Image size 640x480; wide-field fundus photograph of an infant
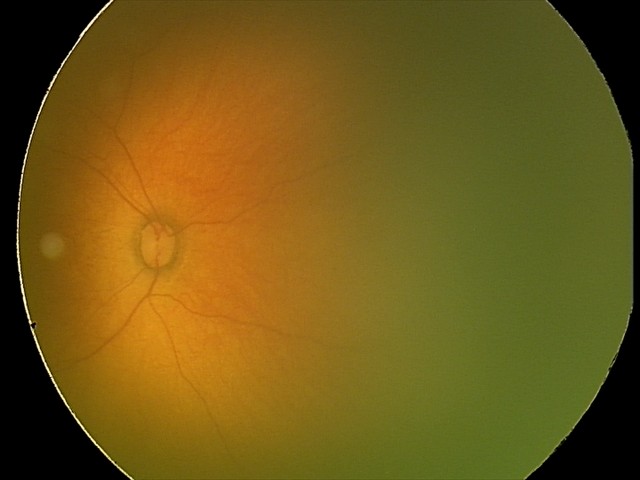
Q: What is the diagnosis from this examination?
A: ROP stage 1